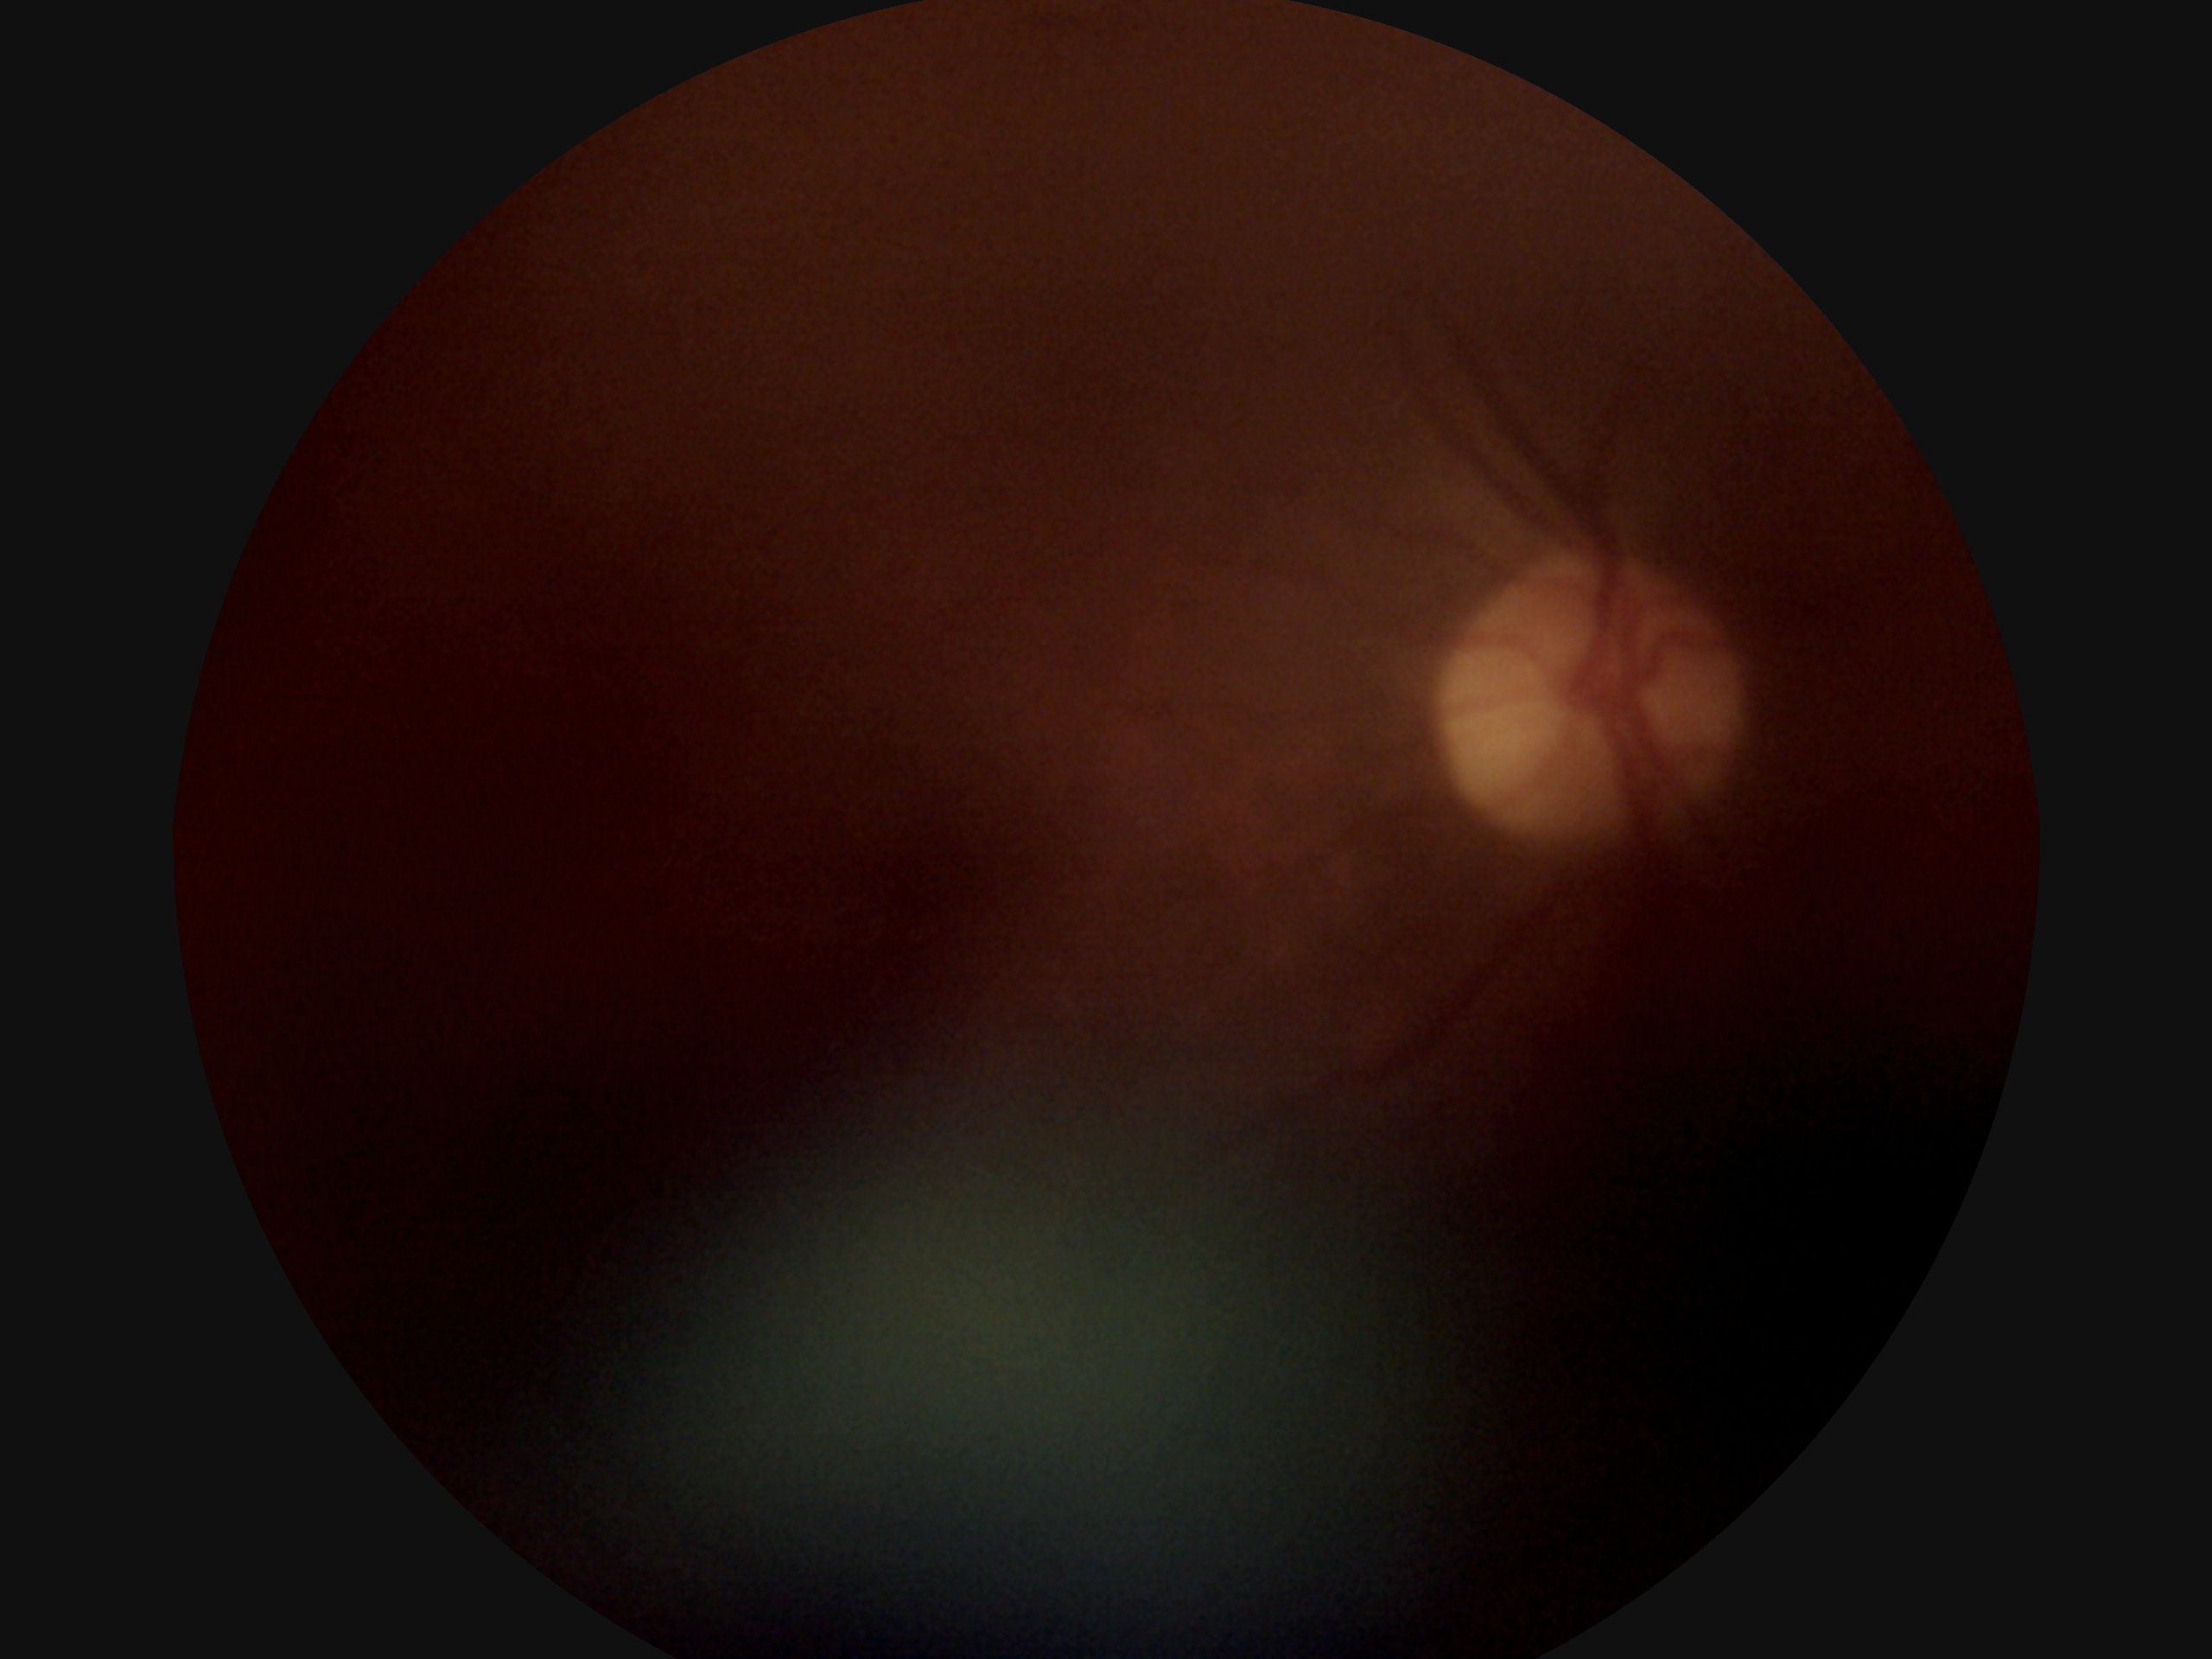
DR grade: ungradable.